Phoenix ICON wide-field infant fundus image; 1240x1240: 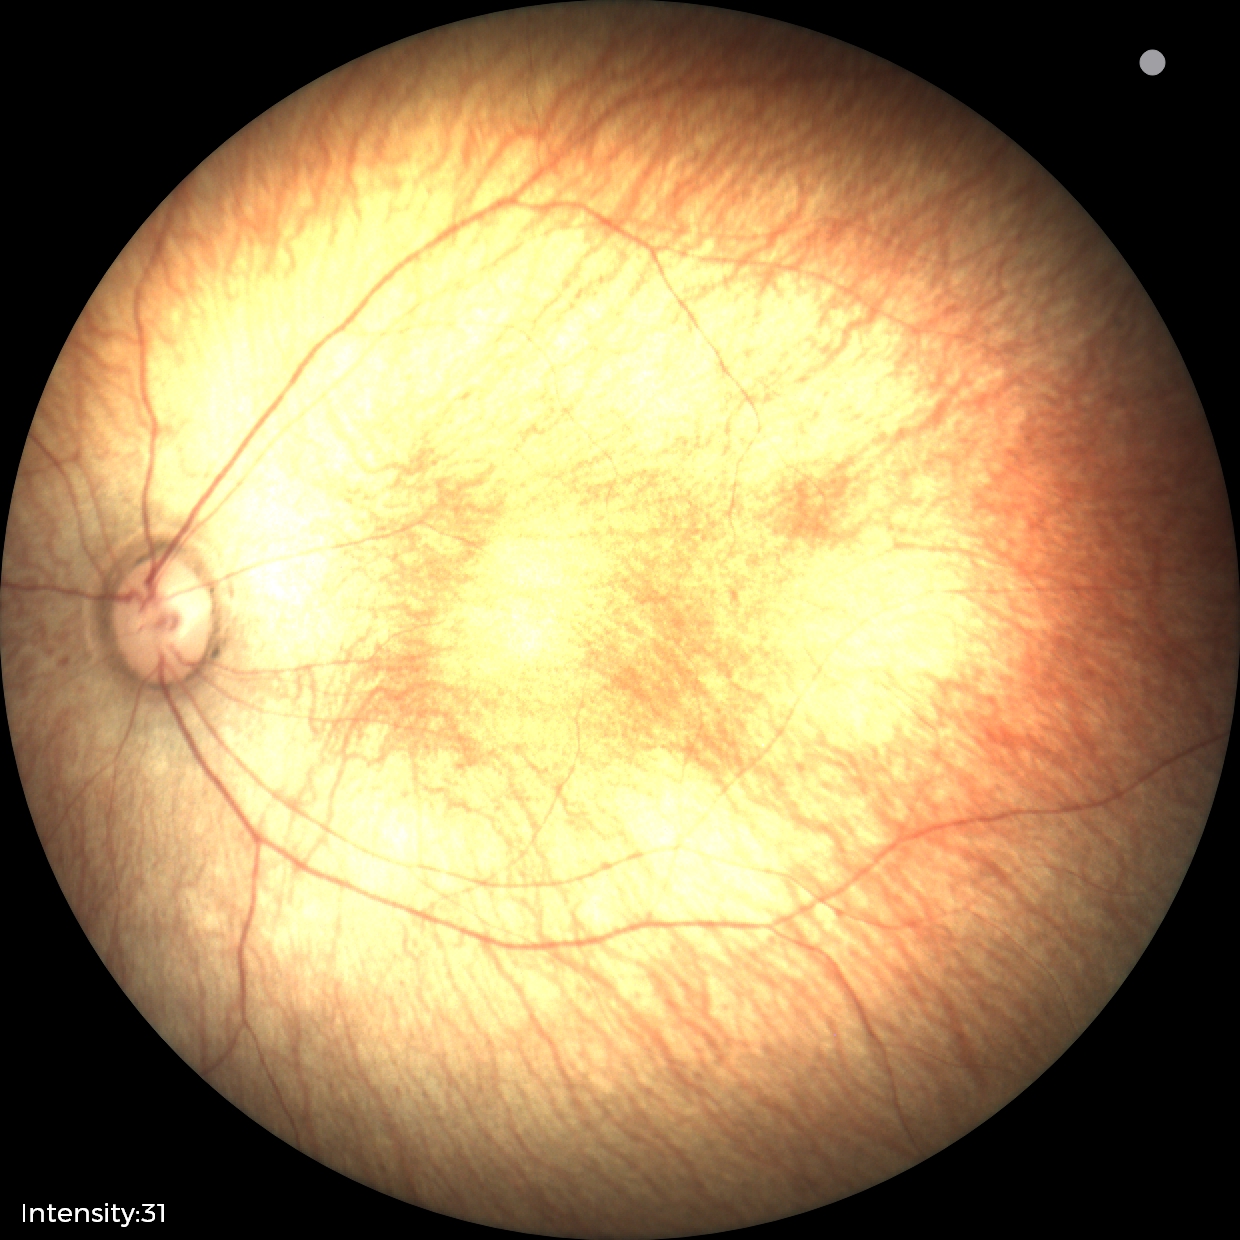

Screening examination with no abnormal retinal findings.